Posterior pole photograph:
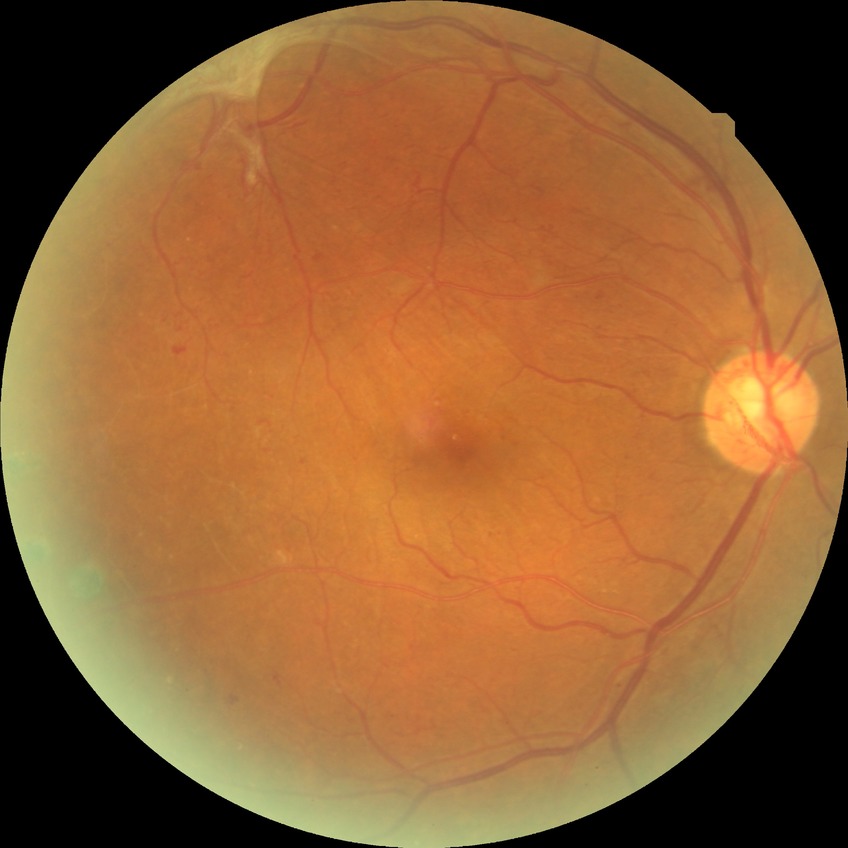

{"davis_grade": "proliferative diabetic retinopathy (PDR)"}